Retinal fundus photograph:
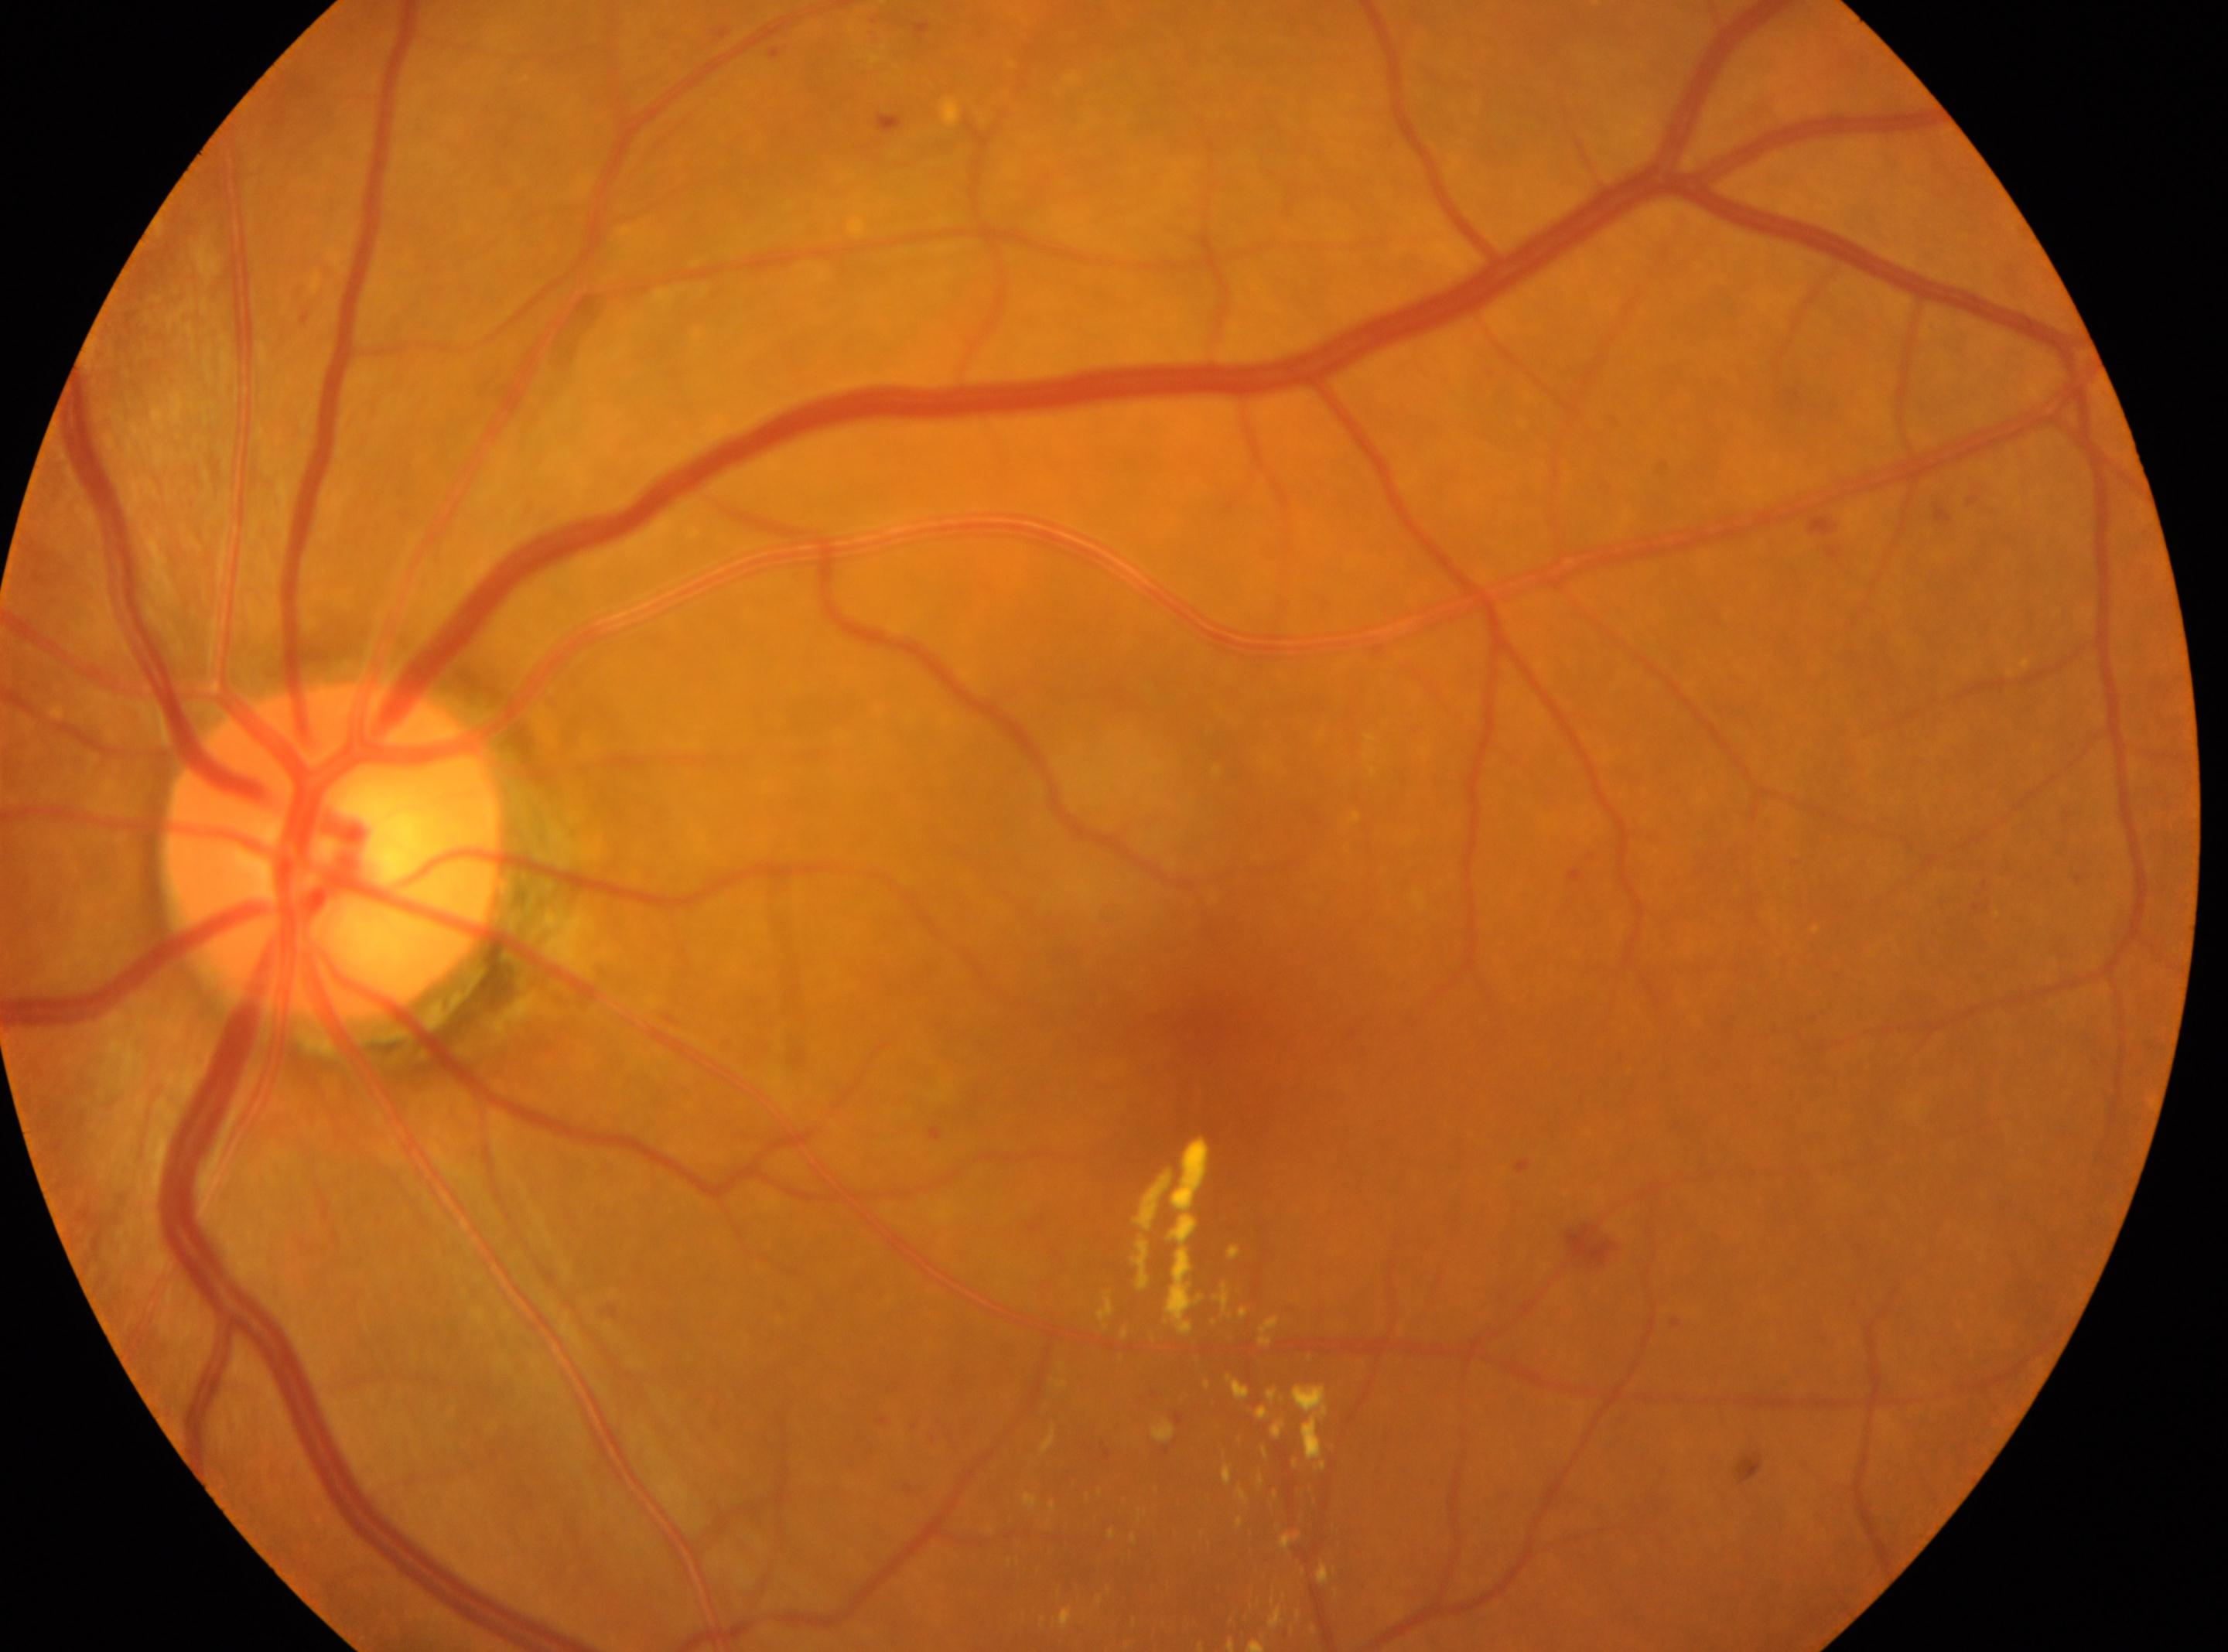

laterality = left eye; DR stage = 2; macula center = 1210px, 1032px; optic nerve head = 331px, 851px.